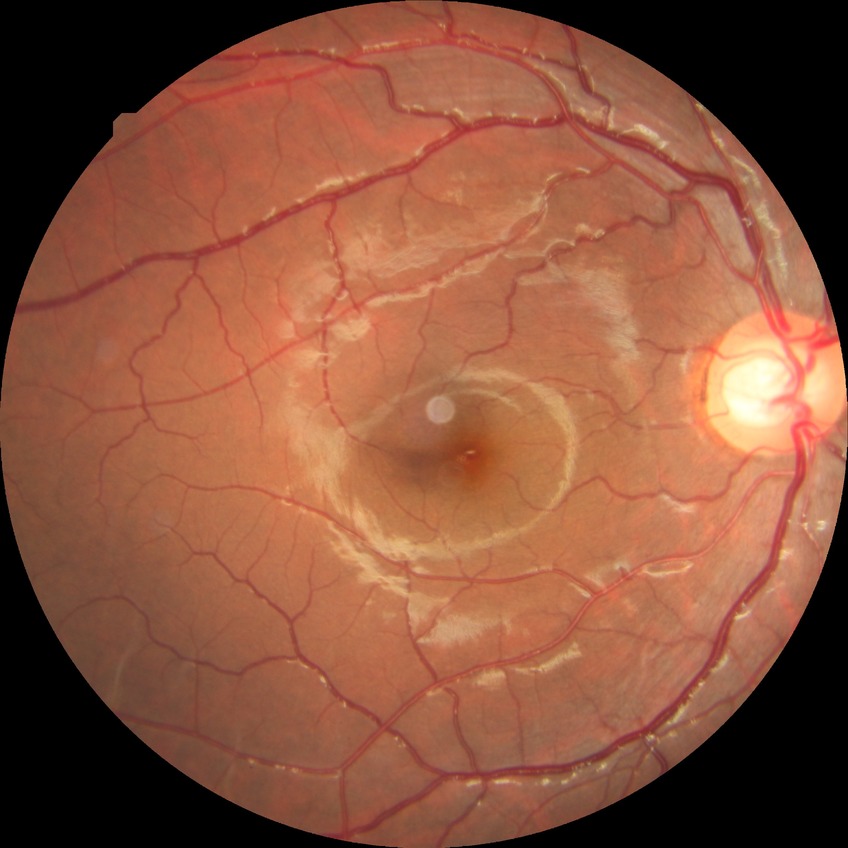 diabetic retinopathy (DR): NDR (no diabetic retinopathy).